45 degree fundus photograph. Camera: NIDEK AFC-230:
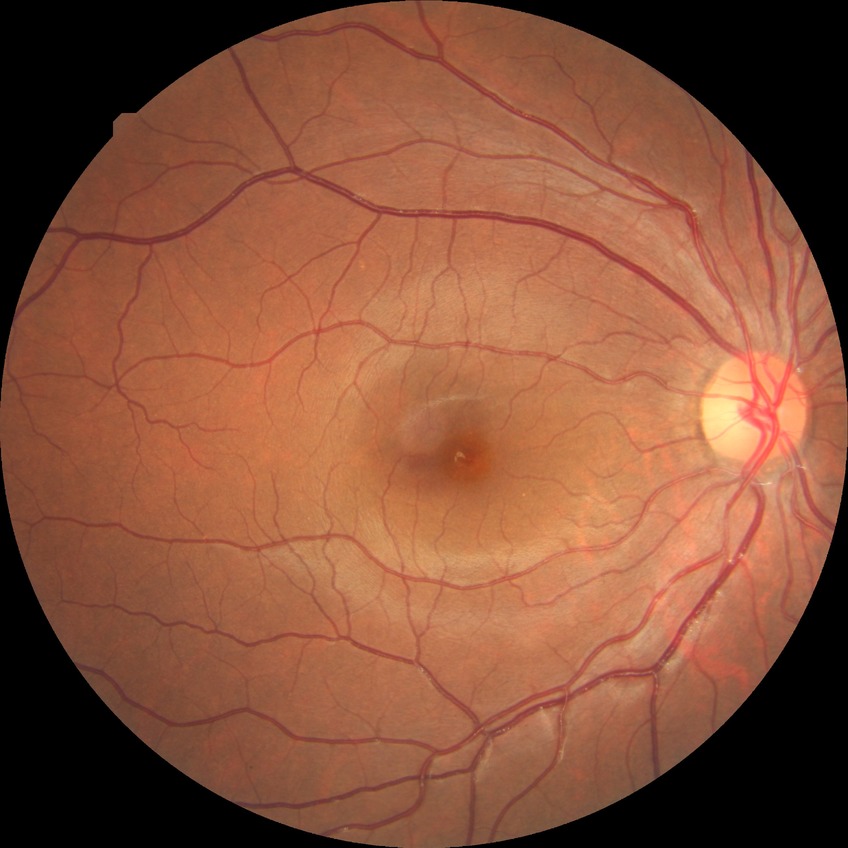

Diabetic retinopathy (DR): no diabetic retinopathy (NDR).